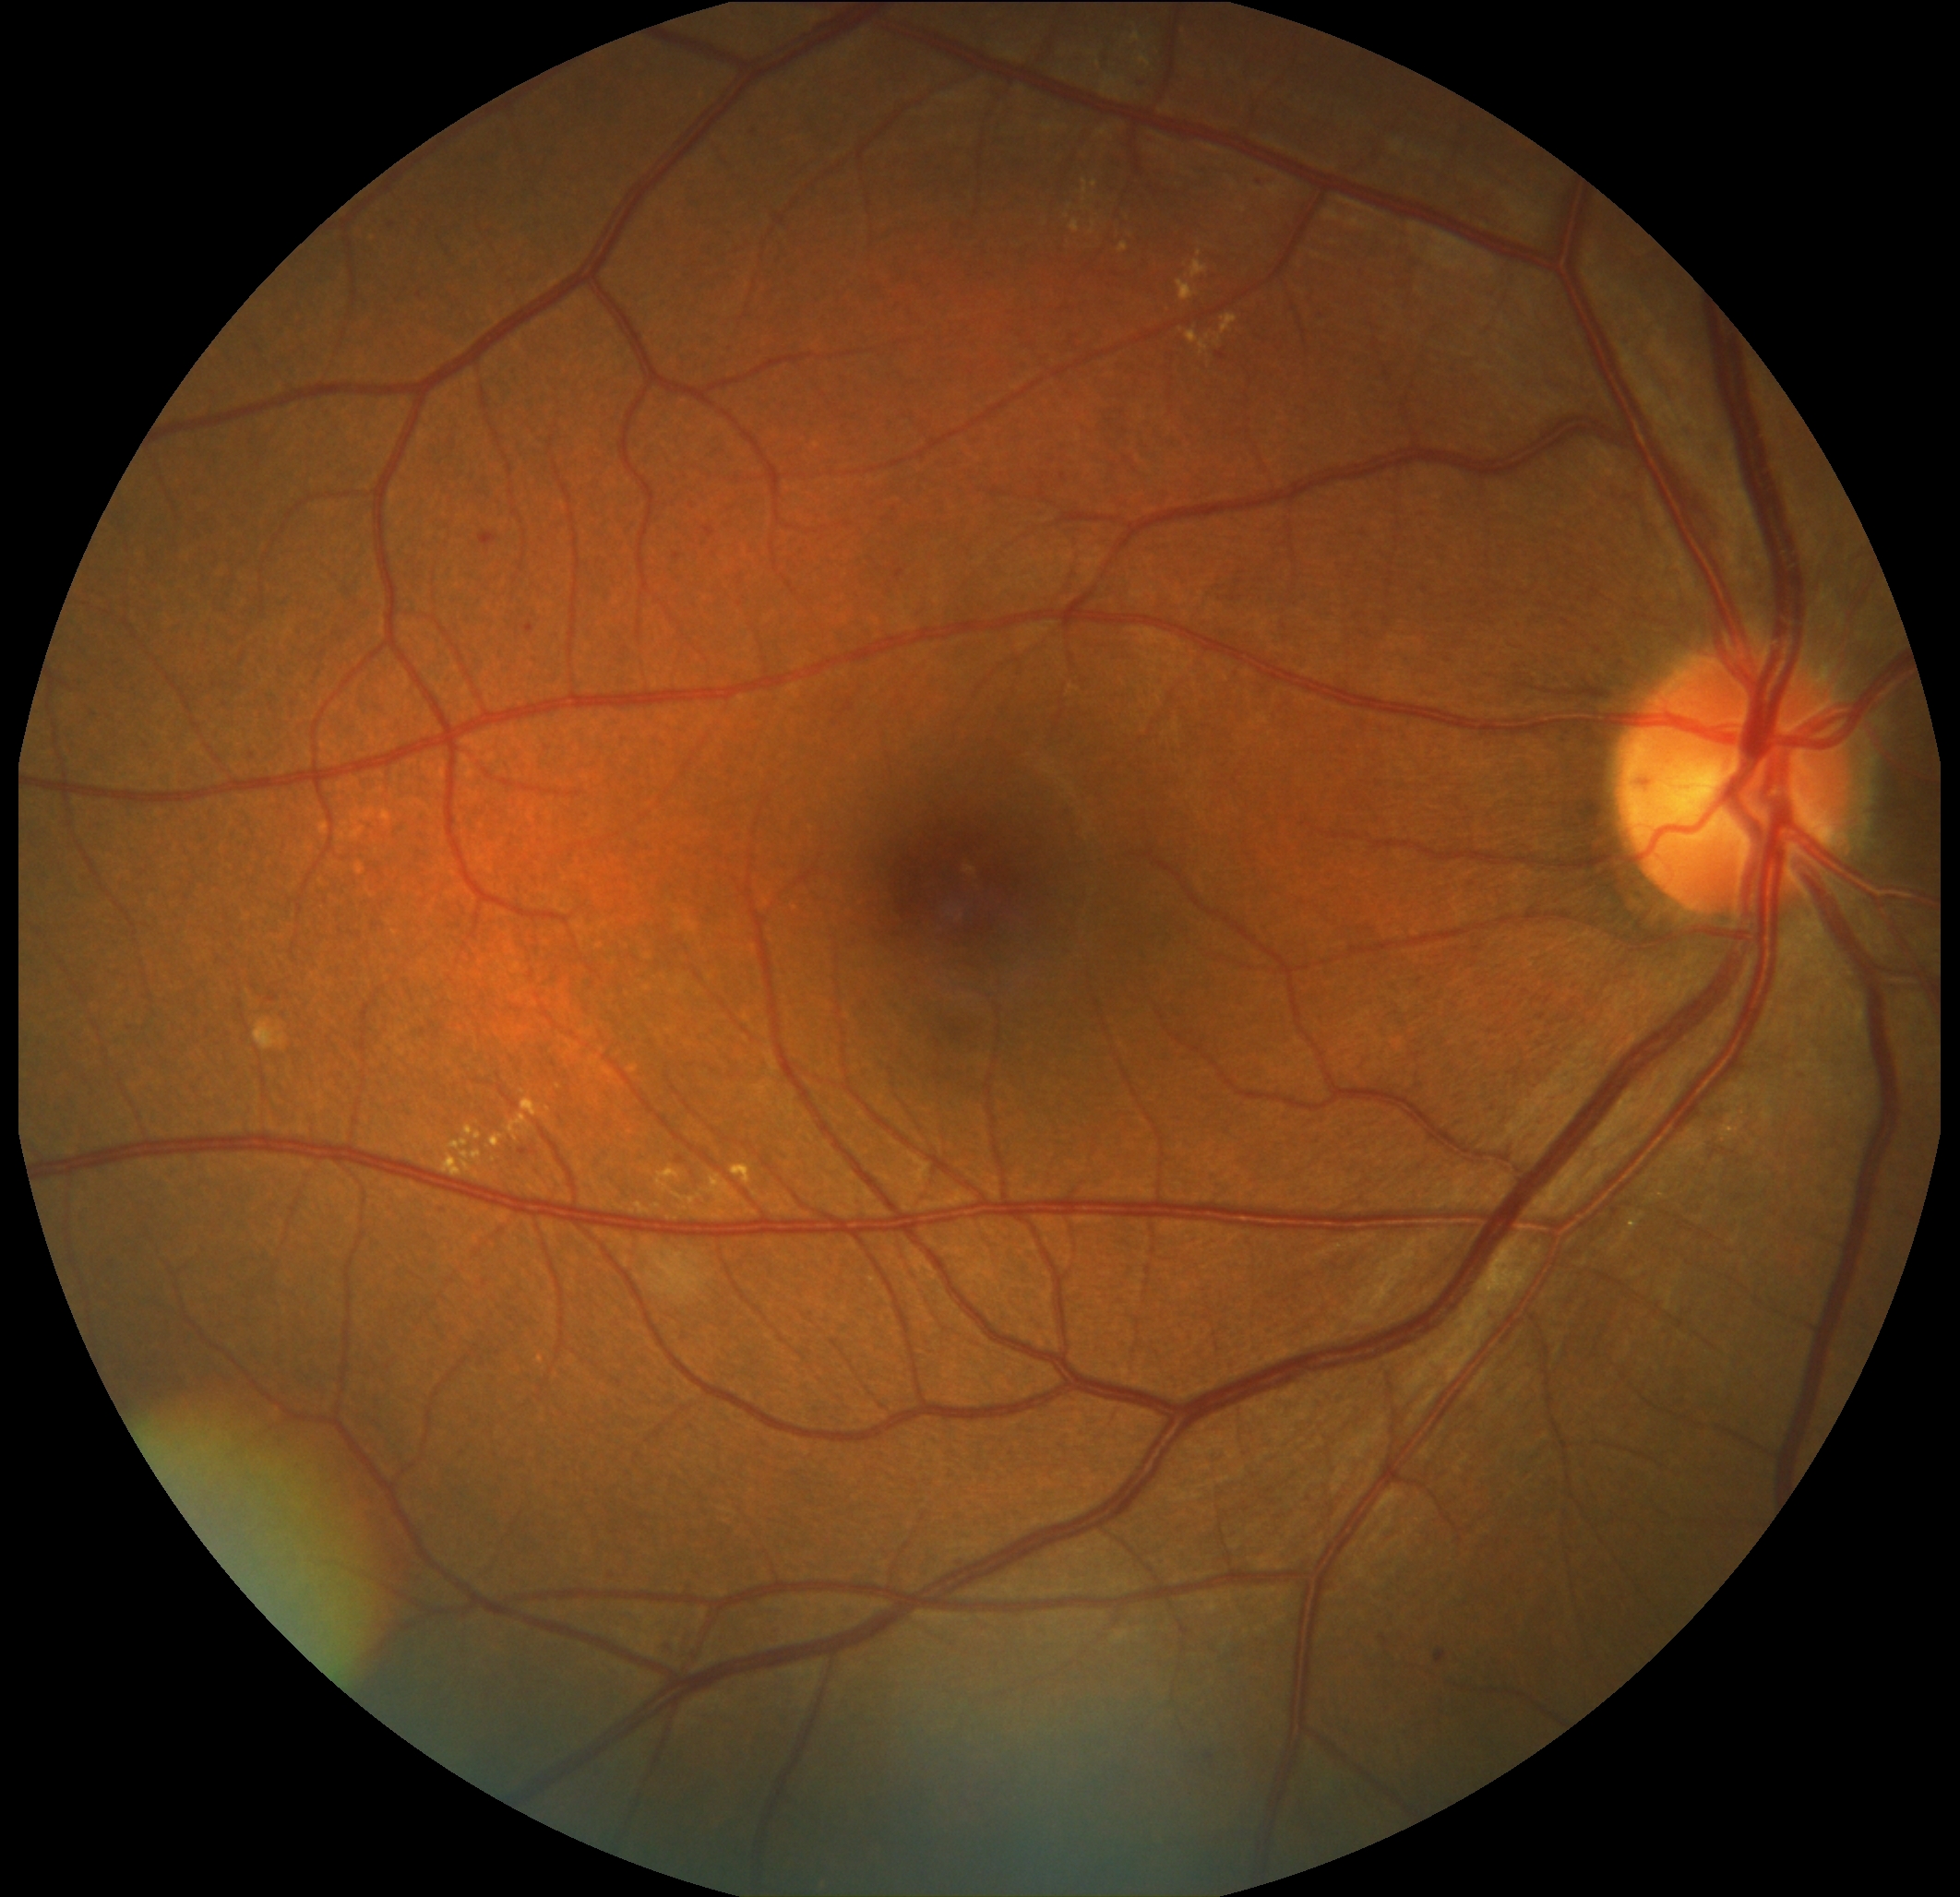

Diabetic retinopathy: grade 2 (moderate NPDR).